Wide-field contact fundus photograph of an infant. Captured with the Natus RetCam Envision (130° field of view).
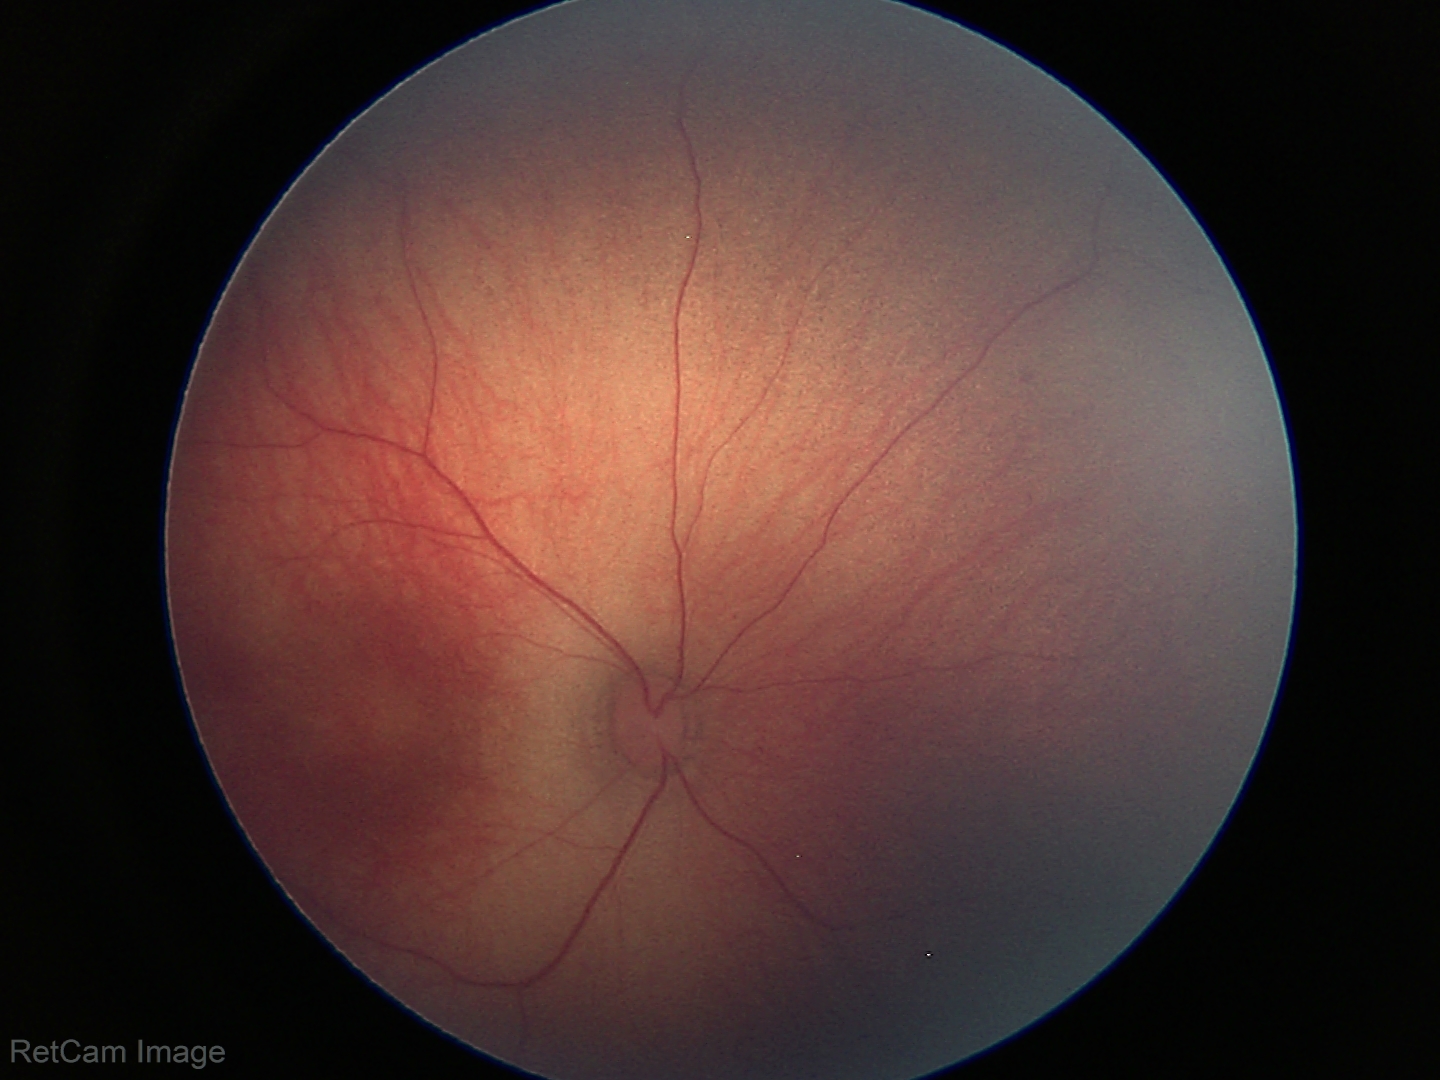

Screening diagnosis = normal.